Acquired with a Remidio Fundus on Phone, image size 1659x2212:
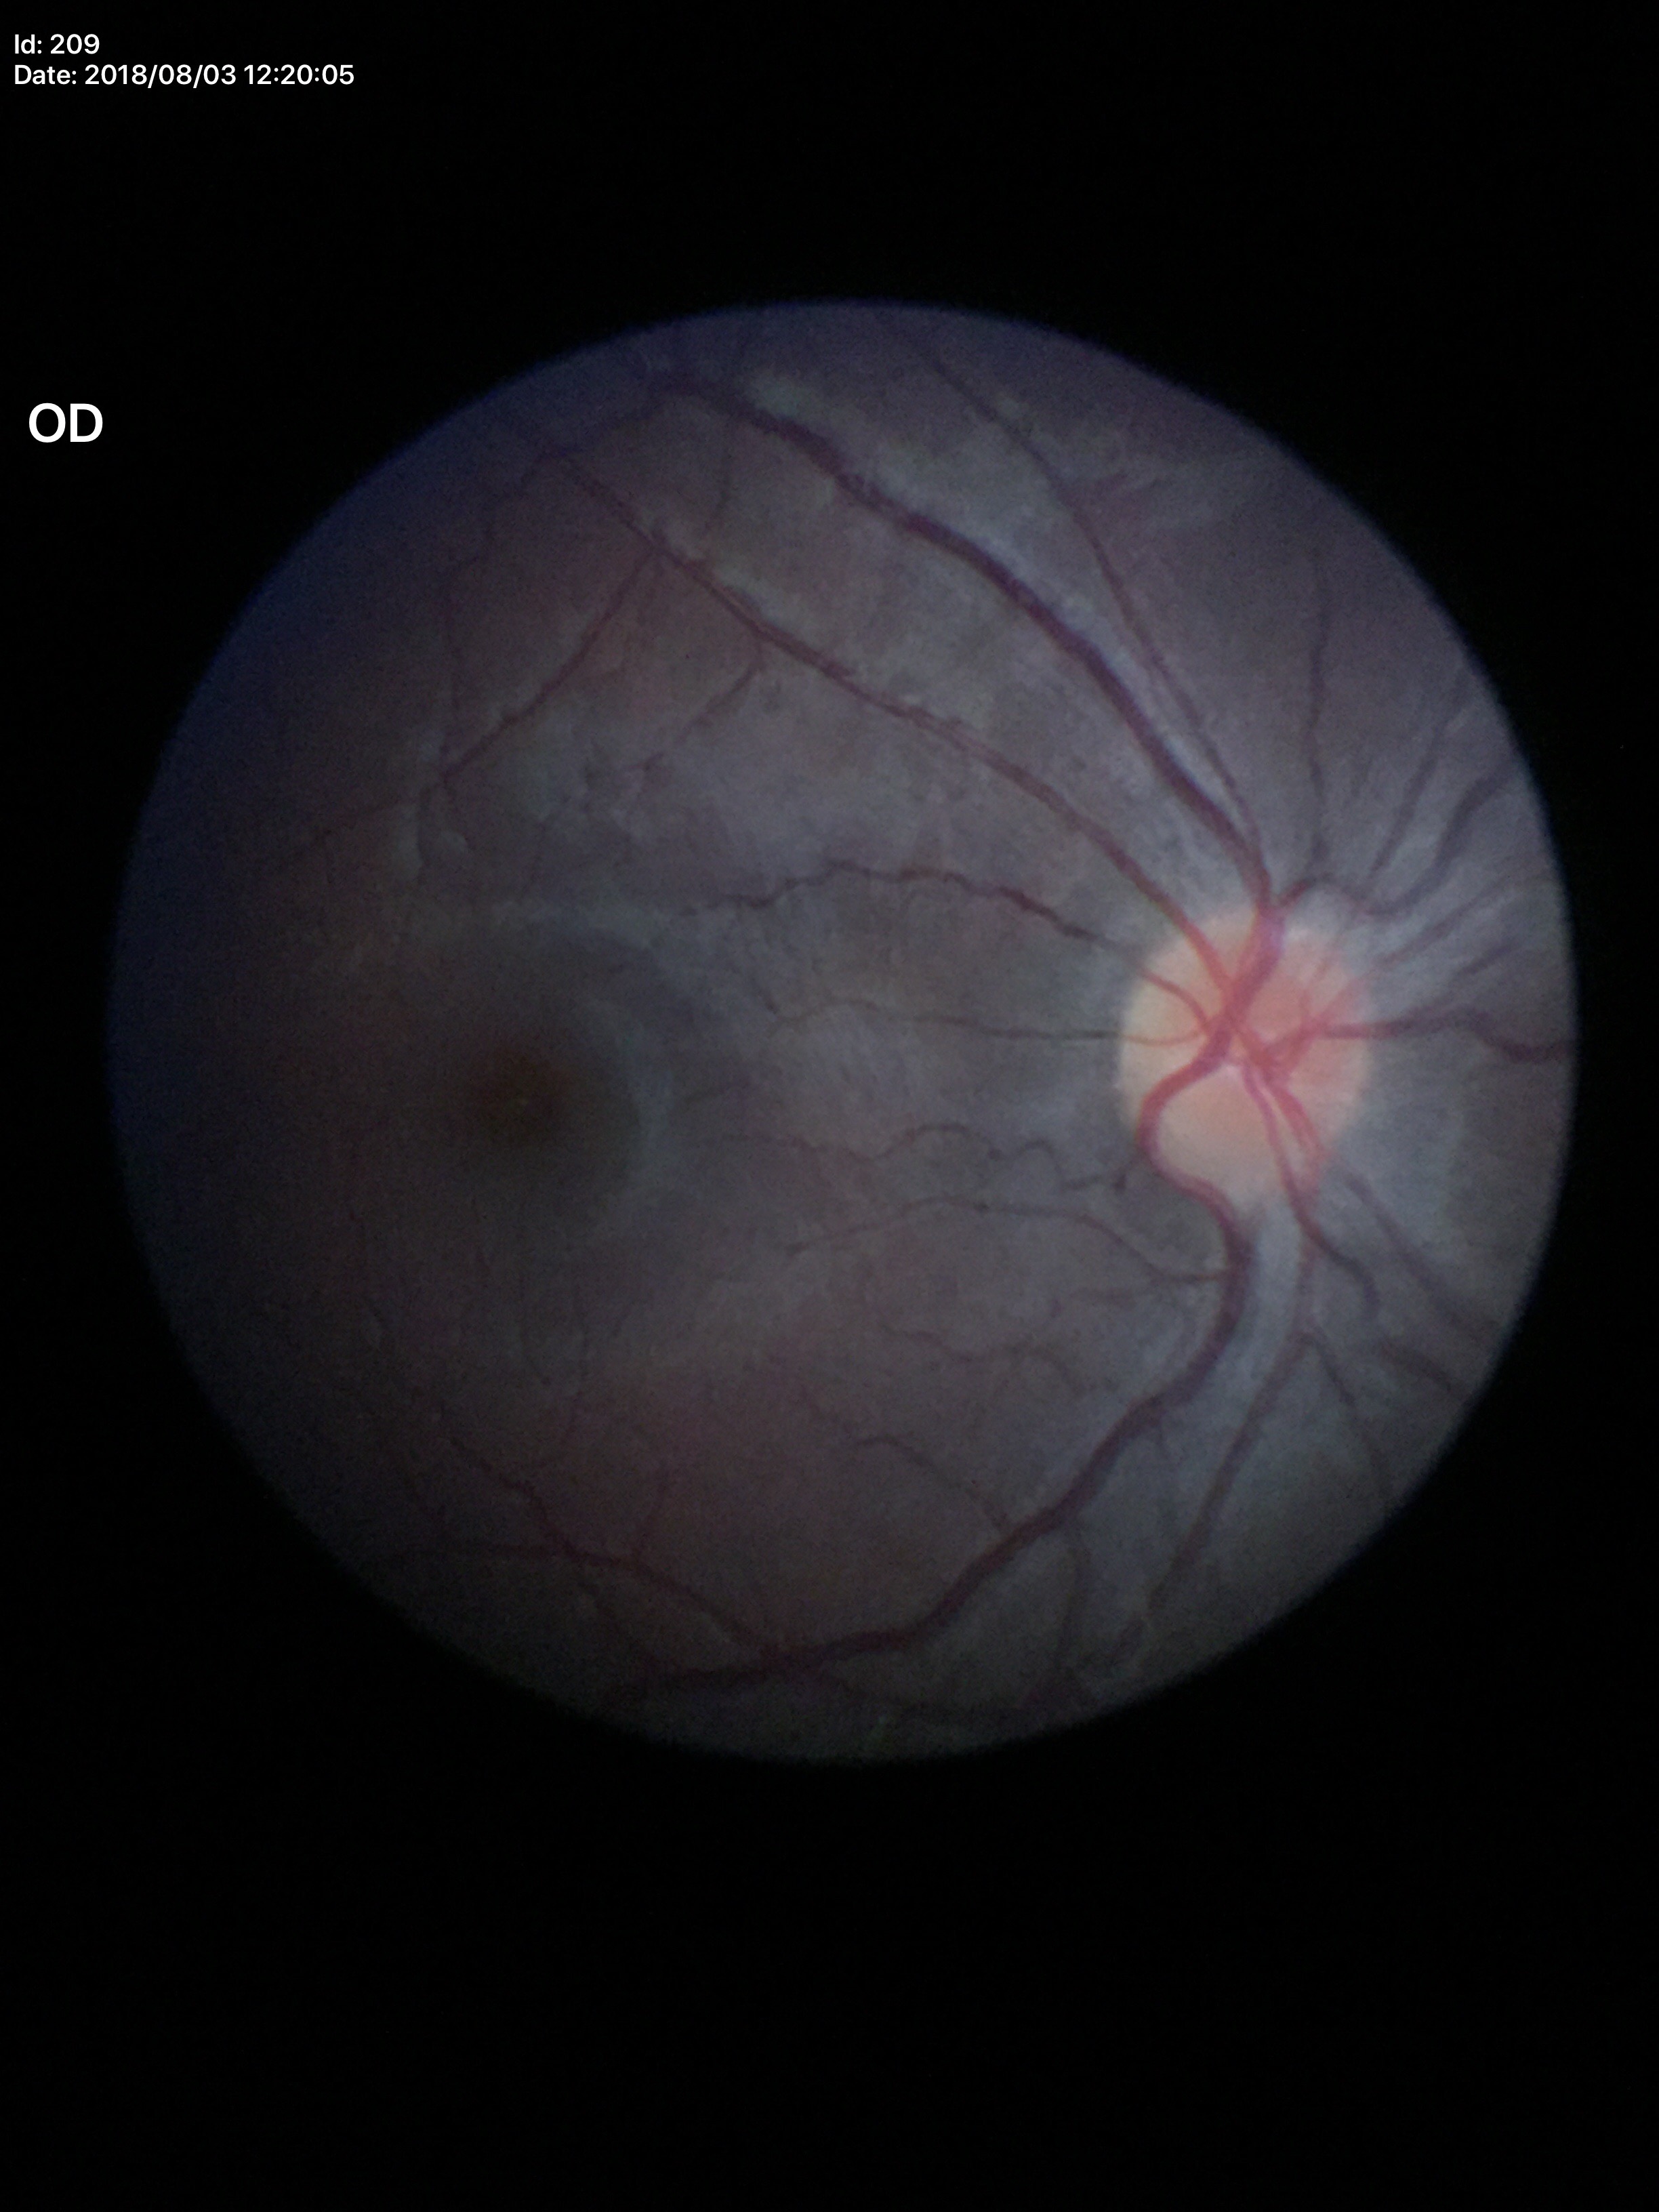
• Glaucoma assessment · no suspicious findings (all 5 graders called normal)
• vertical C/D ratio (VCDR) · 0.35